Infant wide-field fundus photograph: 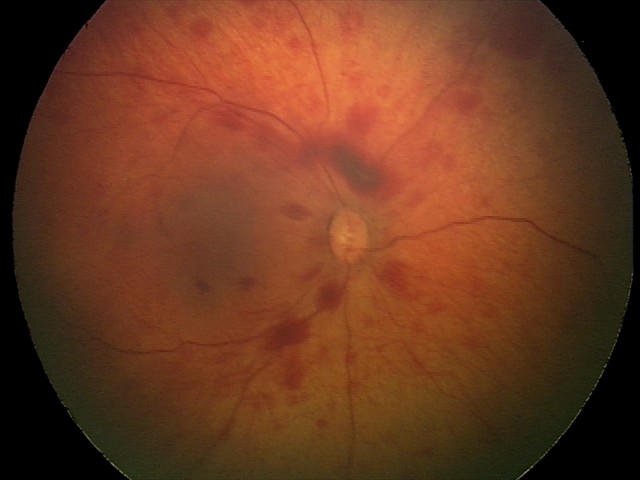

Screening diagnosis = retinal hemorrhages